Wide-field fundus photograph from neonatal ROP screening.
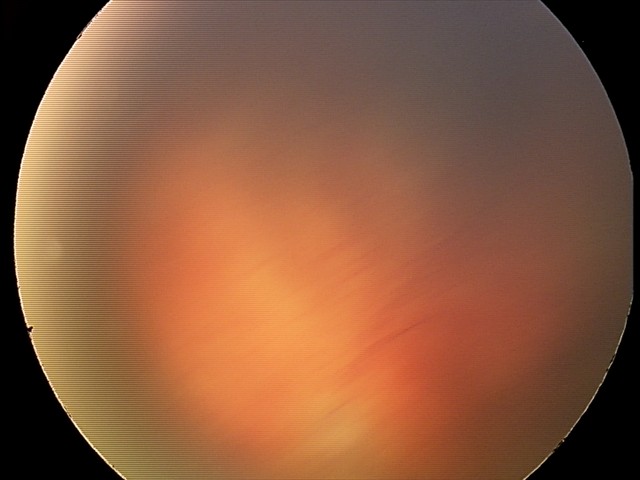

Plus disease present. From an examination with diagnosis of aggressive retinopathy of prematurity.